Graded on the modified Davis scale
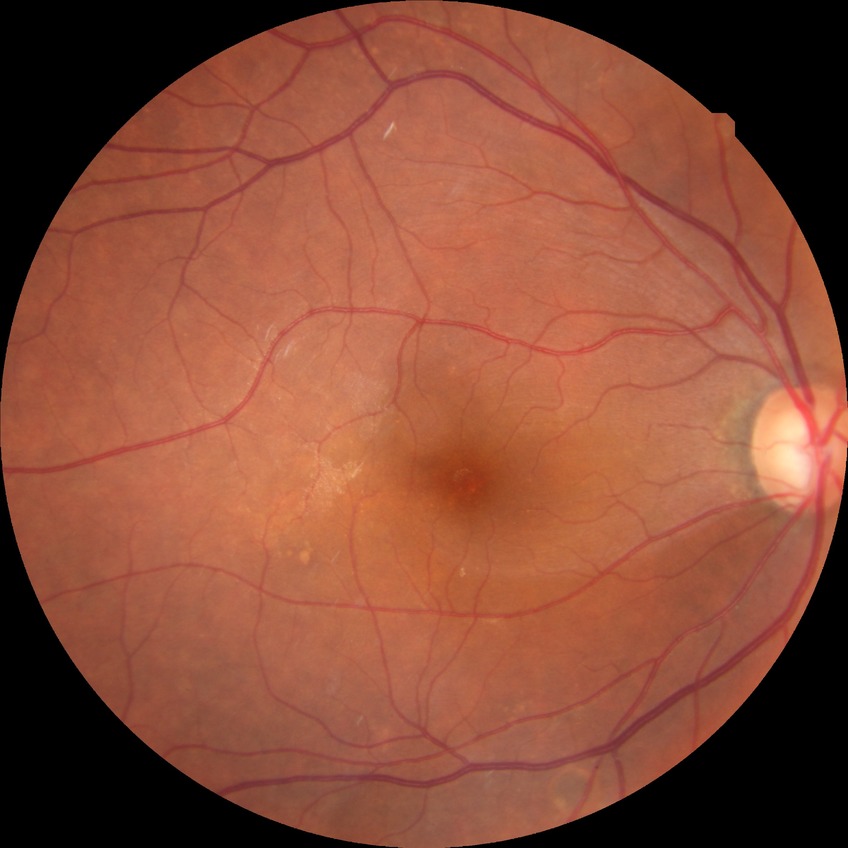   davis_grade: no diabetic retinopathy (NDR)